640x480px; wide-field contact fundus photograph of an infant: 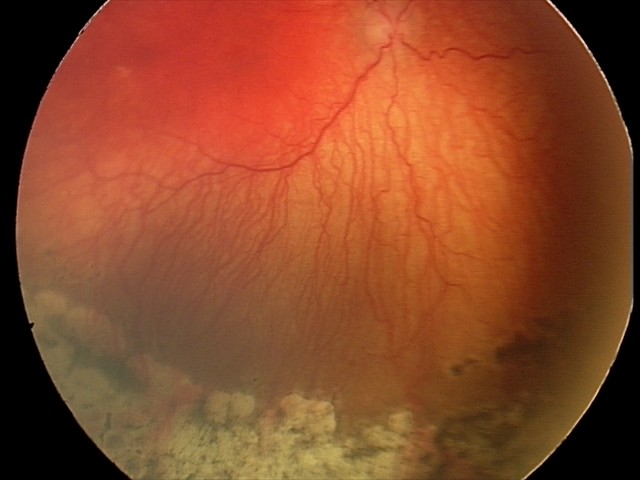
Plus disease present. From an examination with diagnosis of aggressive retinopathy of prematurity.